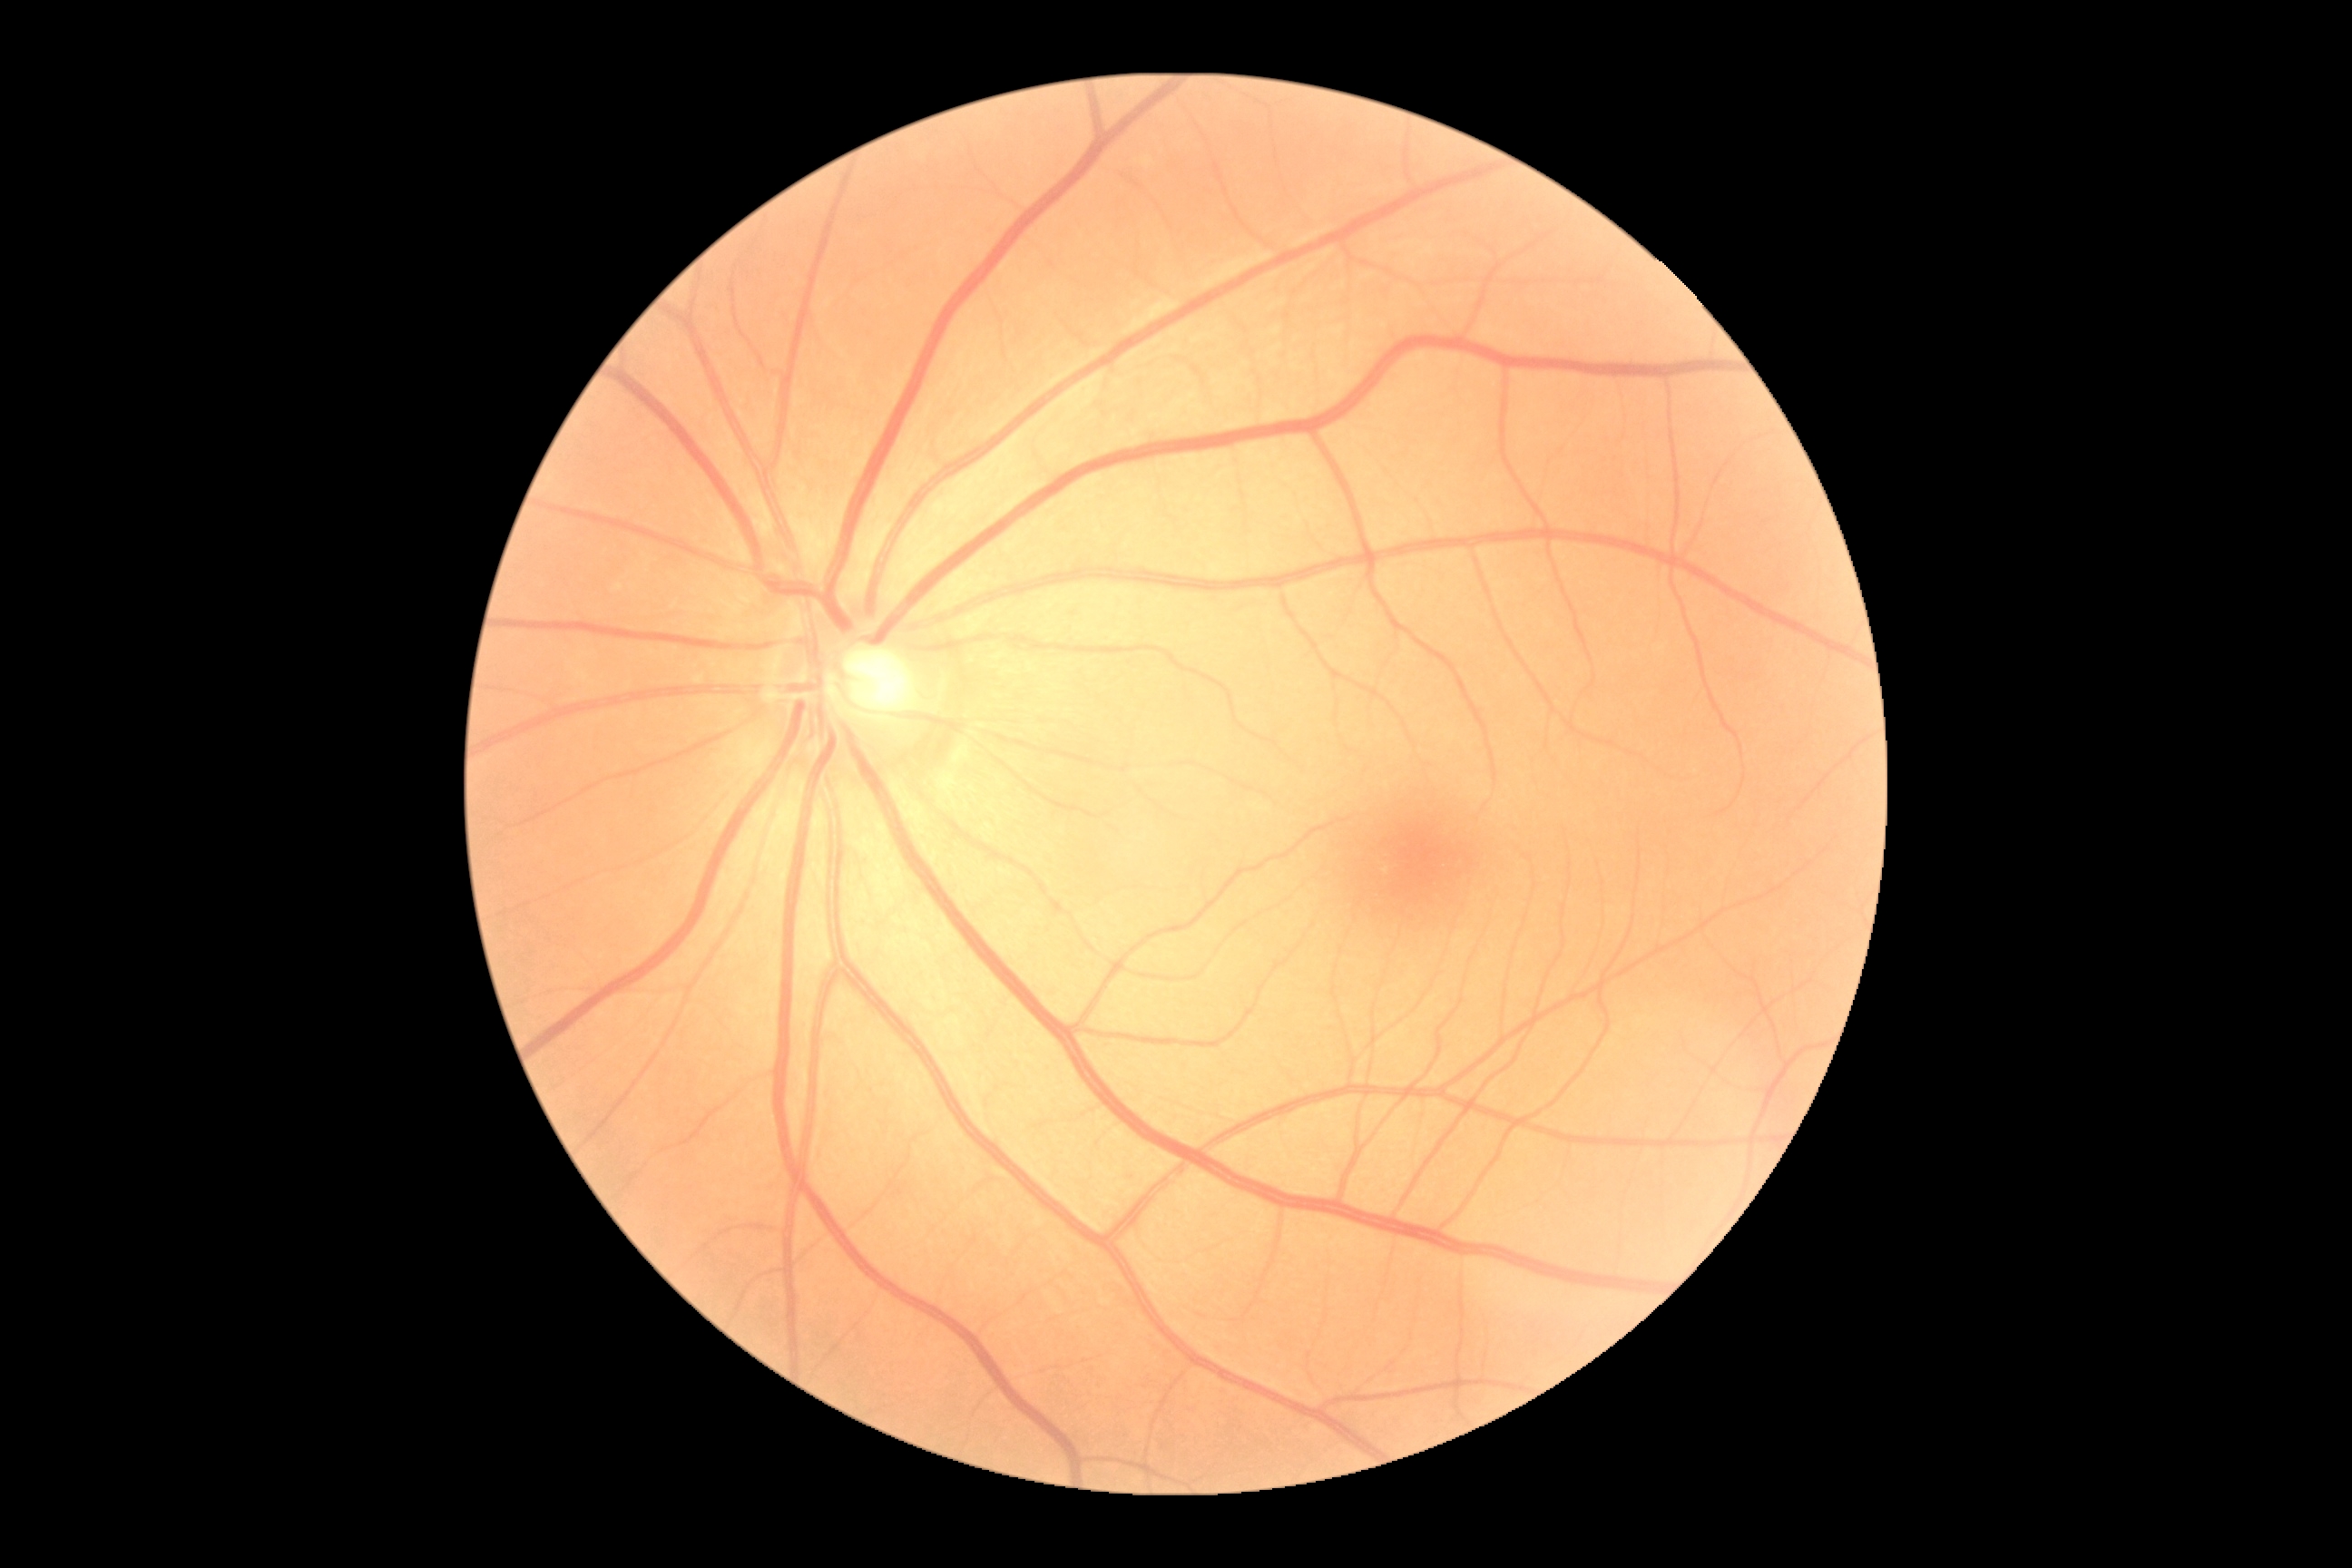

diabetic retinopathy severity = grade 0 (no apparent retinopathy).